Posterior pole photograph, 848 x 848 pixels, acquired with a NIDEK AFC-230: 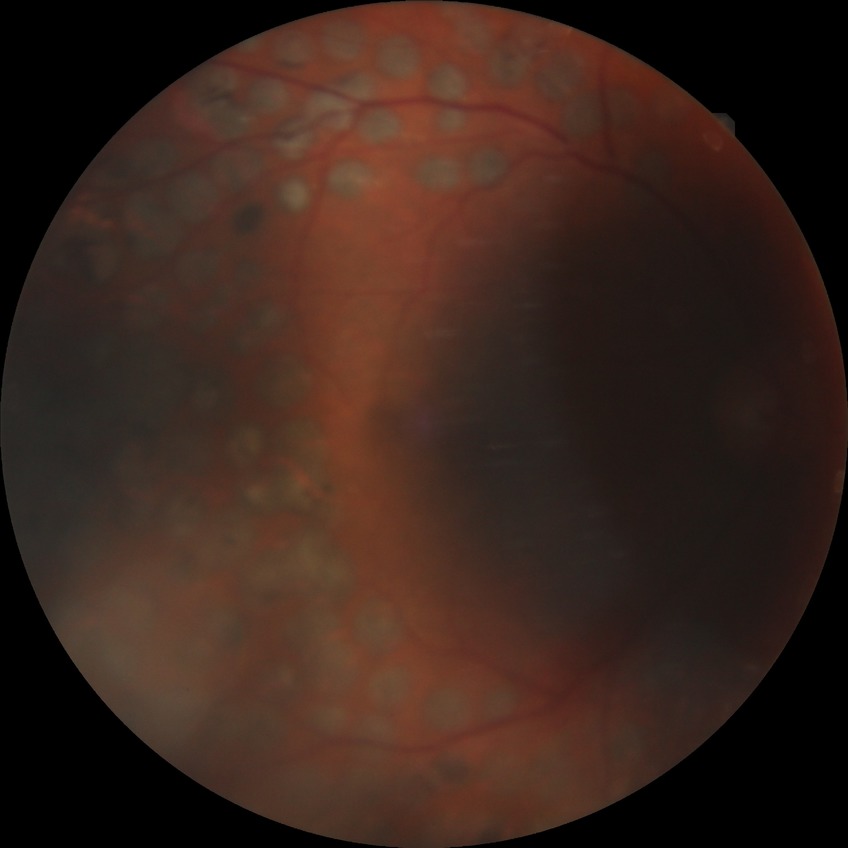

diabetic retinopathy (DR)@proliferative diabetic retinopathy (PDR).